Pediatric wide-field fundus photograph; 1240x1240
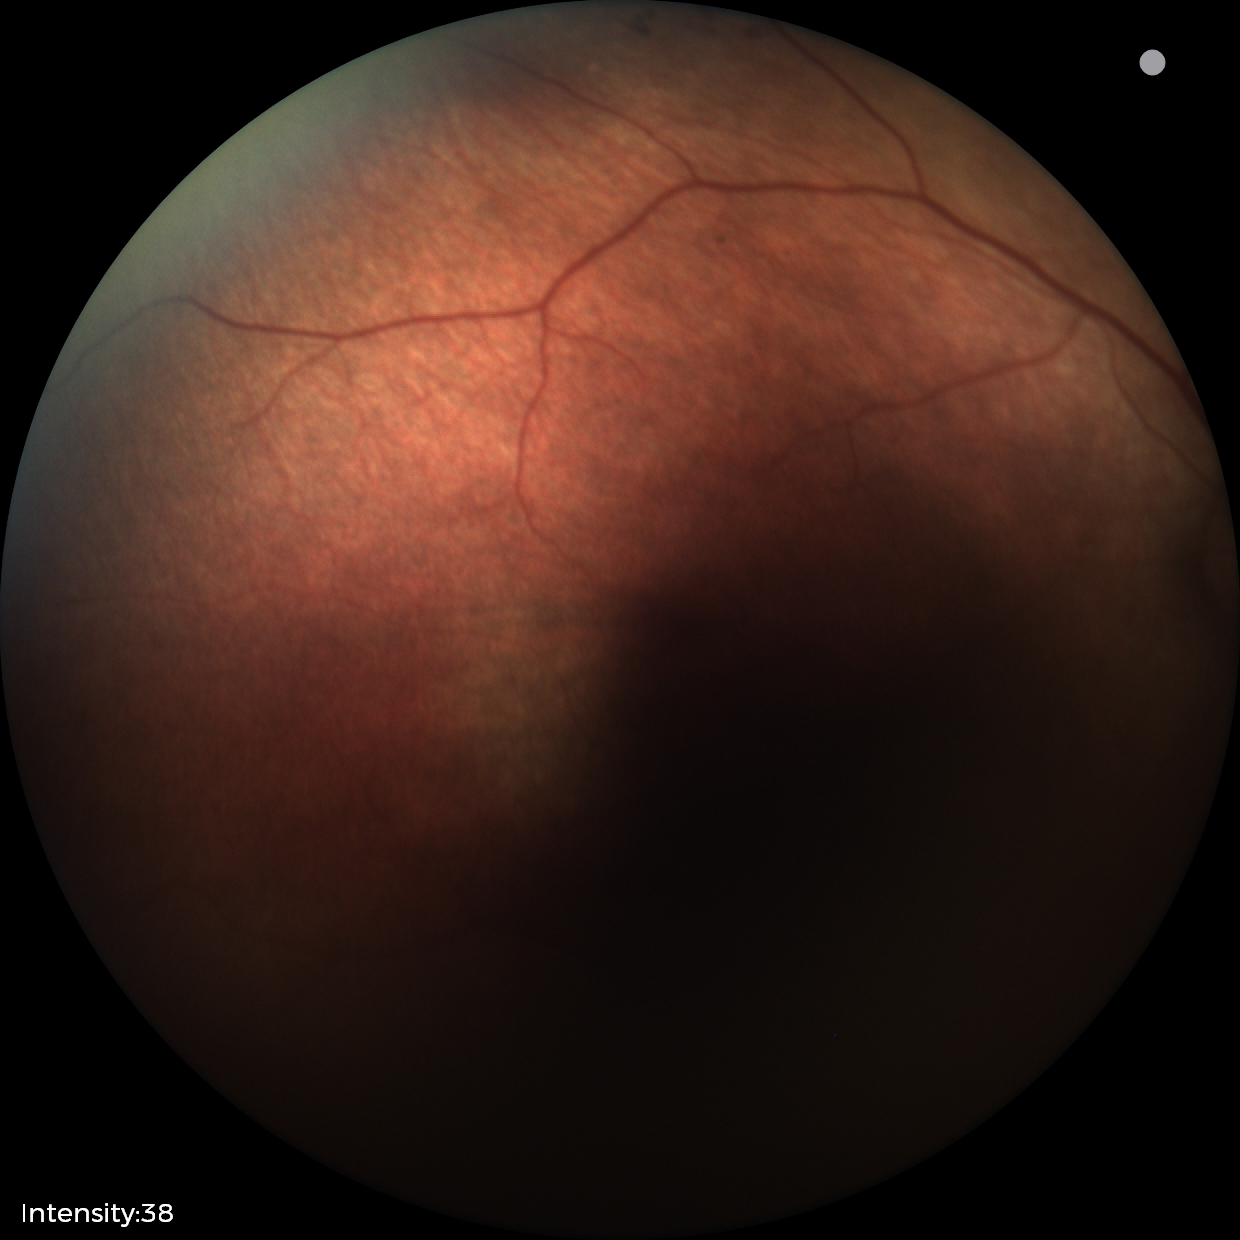
Screening examination diagnosed as physiological.